848x848px.
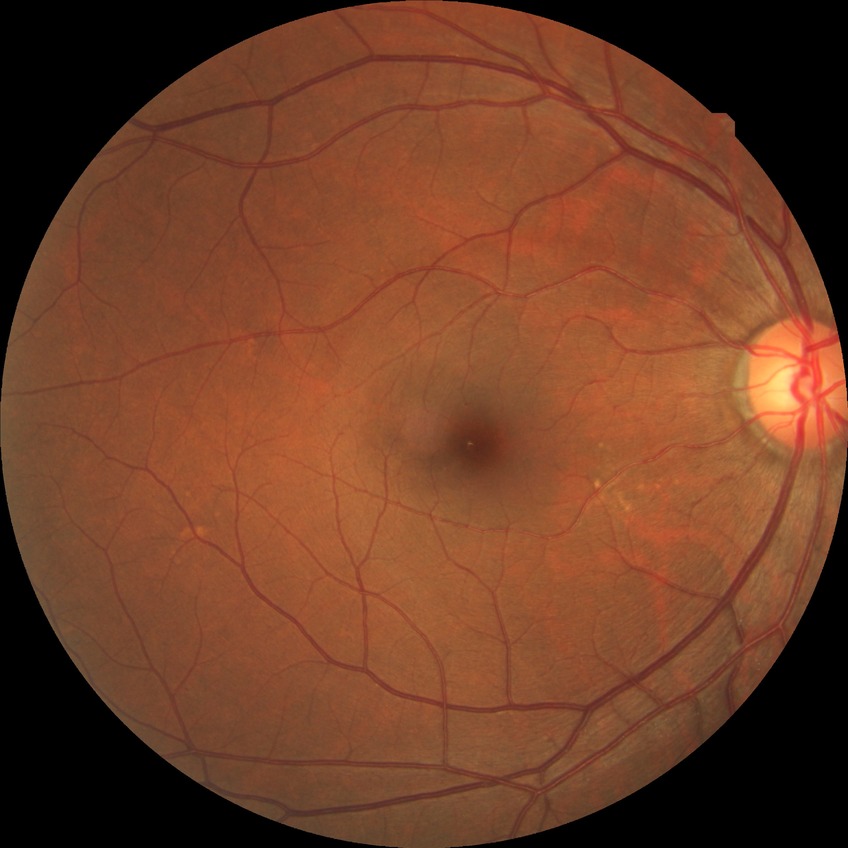
Diabetic retinopathy severity is no diabetic retinopathy.